Wide-field fundus photograph from neonatal ROP screening; 640x480px; Clarity RetCam 3, 130° FOV
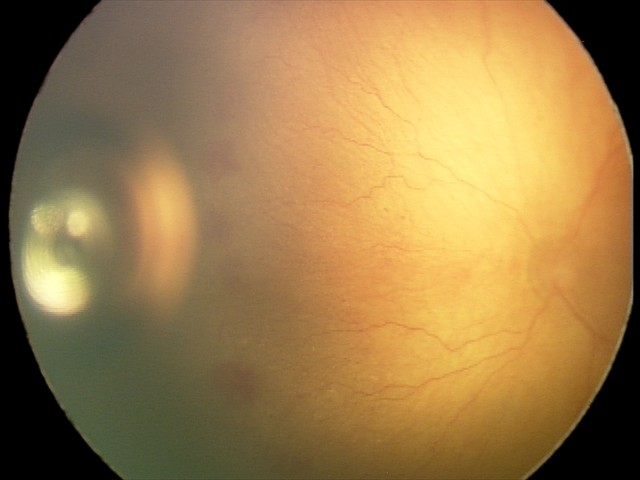
Q: What is the plus-form classification?
A: plus disease — abnormal dilation and tortuosity of the posterior pole retinal vessels
Q: What is the screening diagnosis?
A: aggressive retinopathy of prematurity (A-ROP)